Color fundus image: 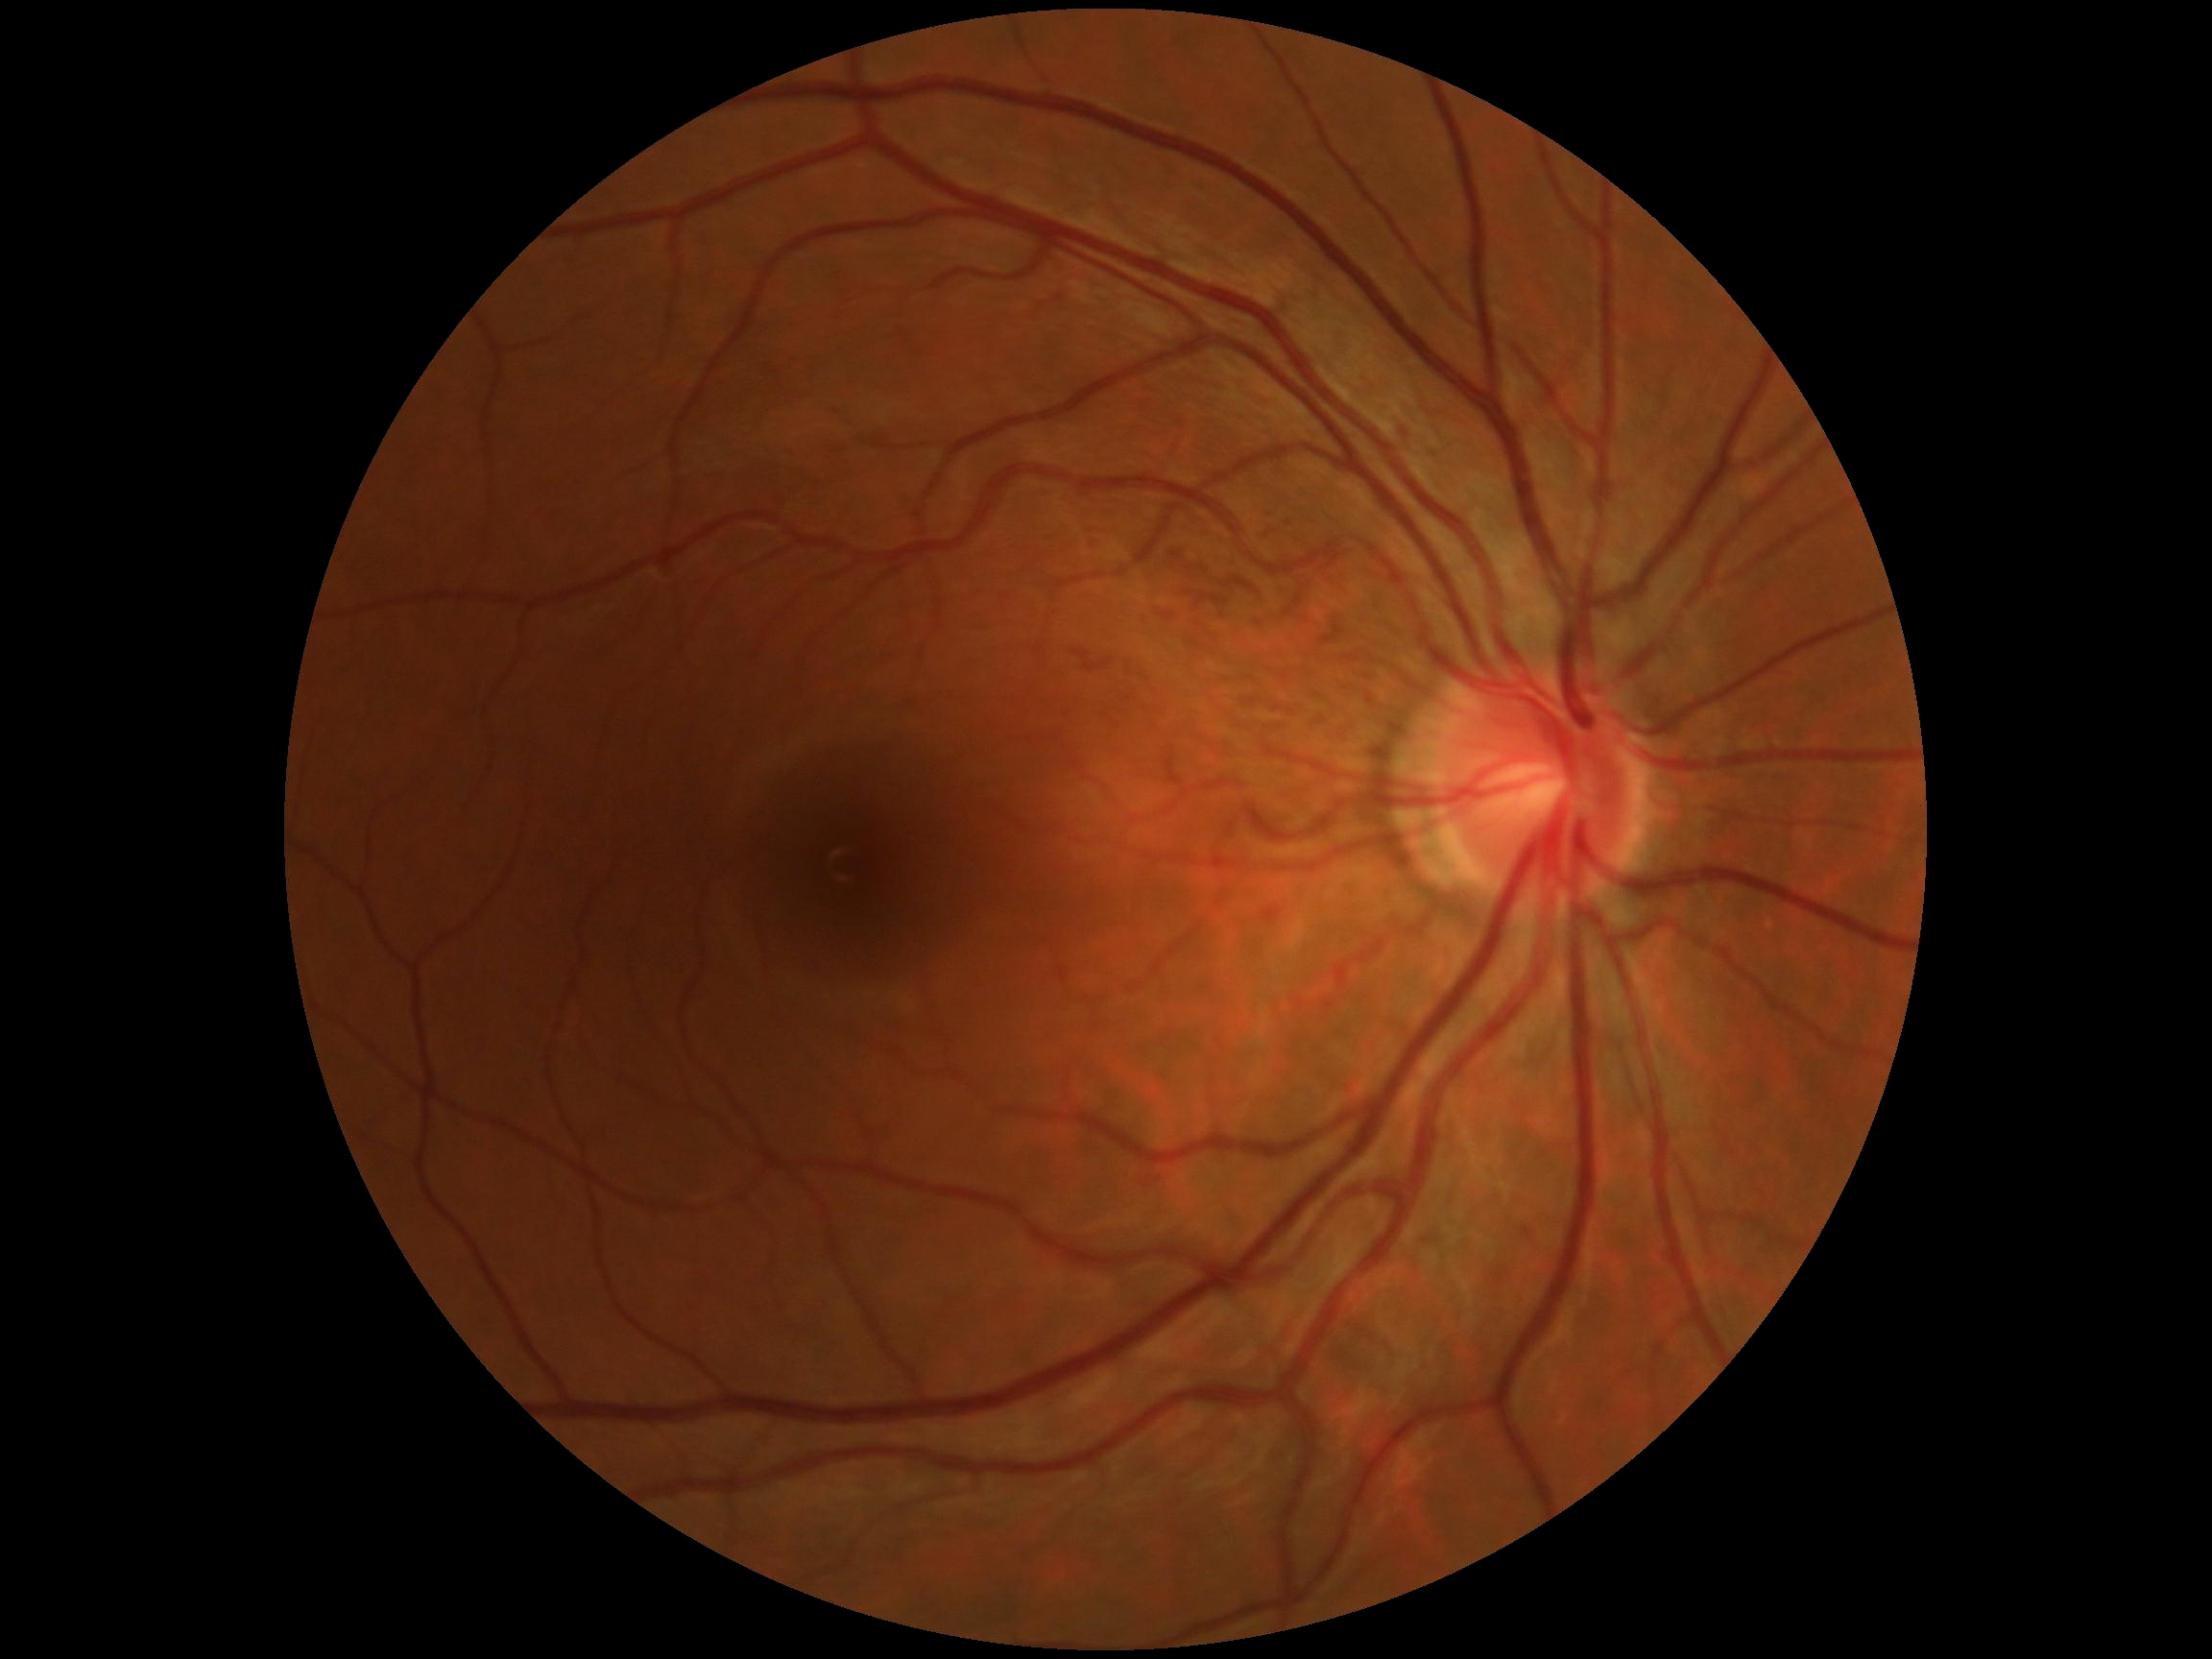
– DR — no apparent diabetic retinopathy (grade 0)
– DR impression — no signs of DR